Camera: Clarity RetCam 3 (130° FOV); wide-field fundus image from infant ROP screening — 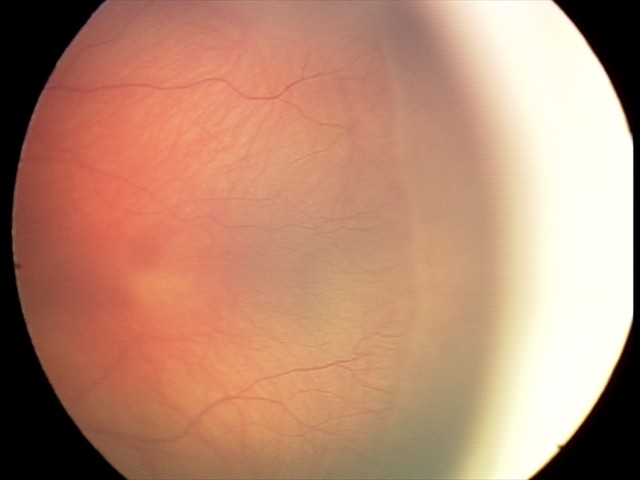

No plus disease.
Examination diagnosed as ROP stage 2.